Posterior pole field covering the optic disc and macula. Captured after pupil dilation:
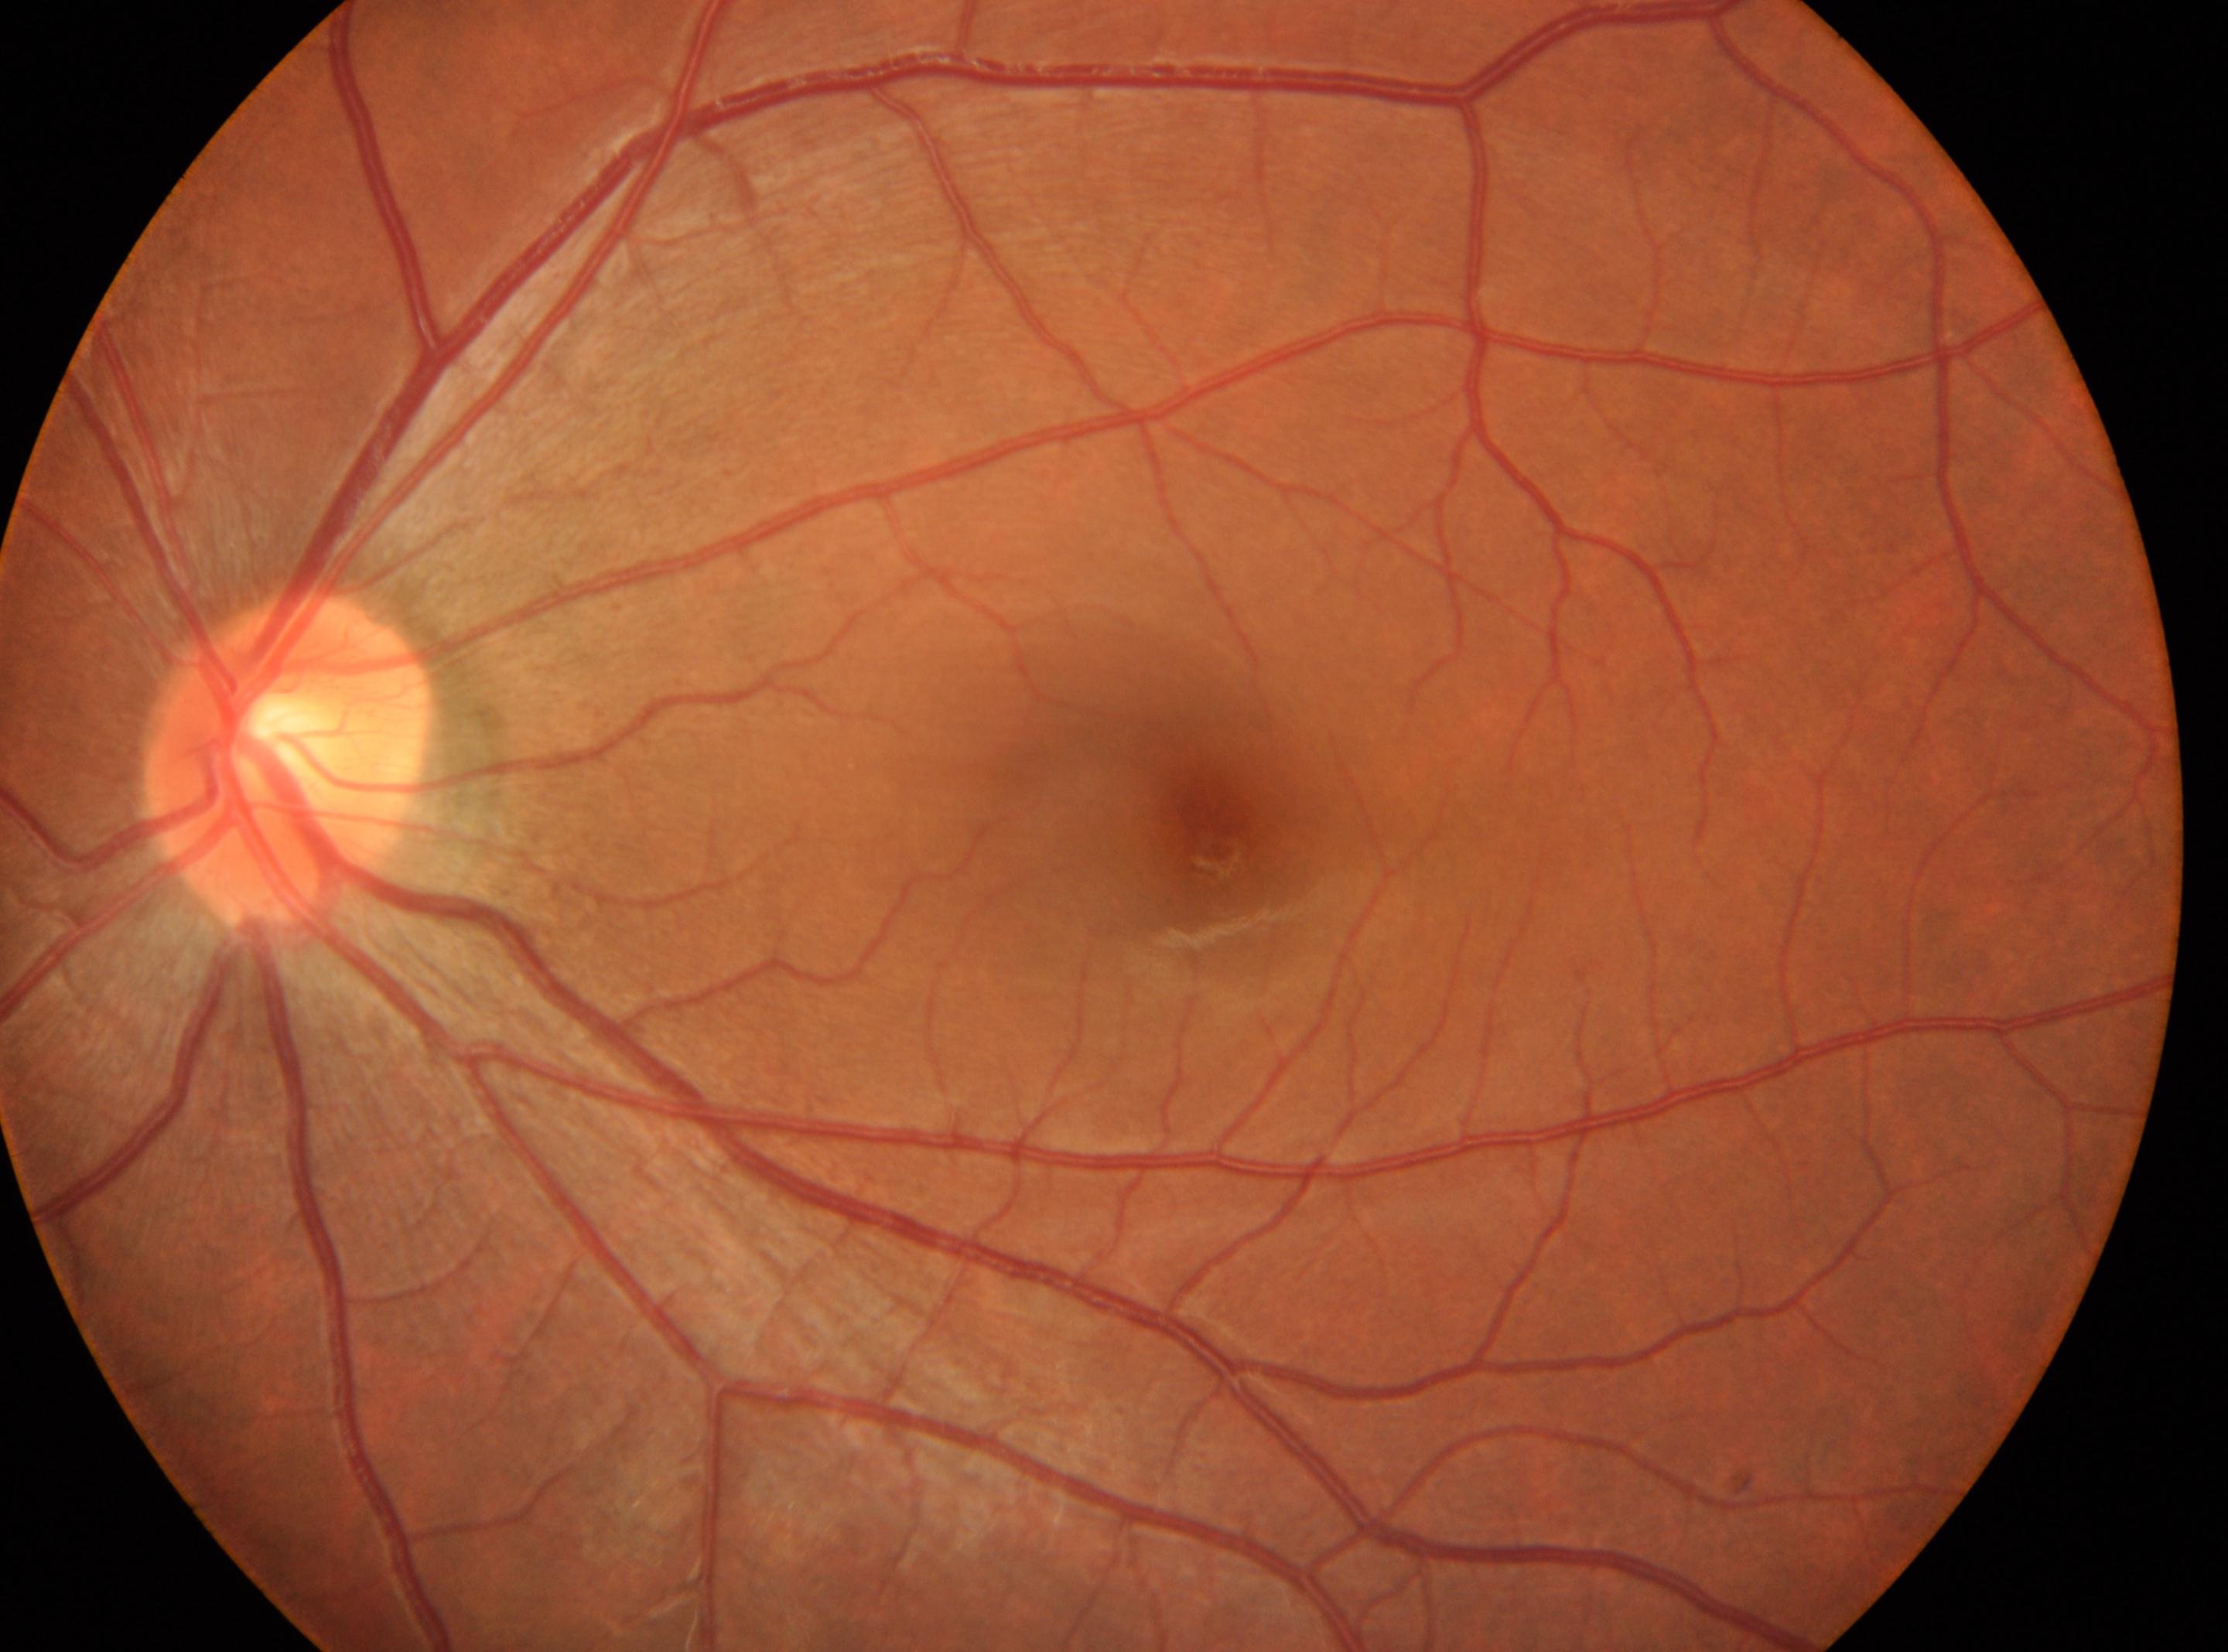 * ONH · (286, 761)
* DR stage · grade 0 (no apparent retinopathy)
* eye · OS
* fovea centralis · (1216, 852)
* DR impression · No diabetic retinopathy identified